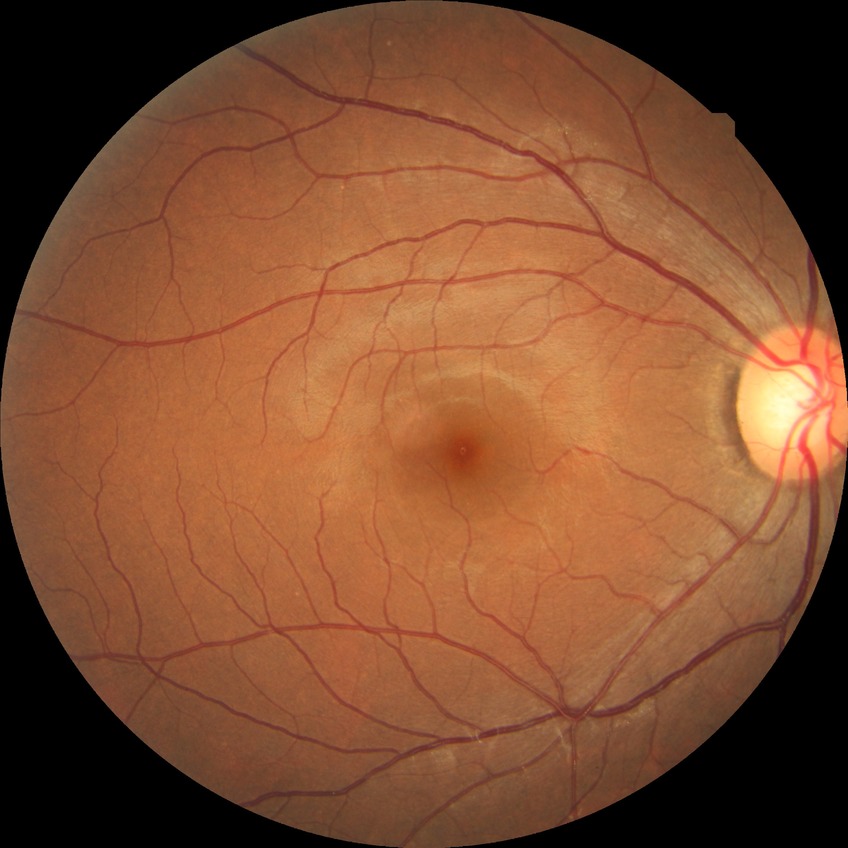 - modified Davis grading: no diabetic retinopathy